NIDEK AFC-230; nonmydriatic fundus photograph
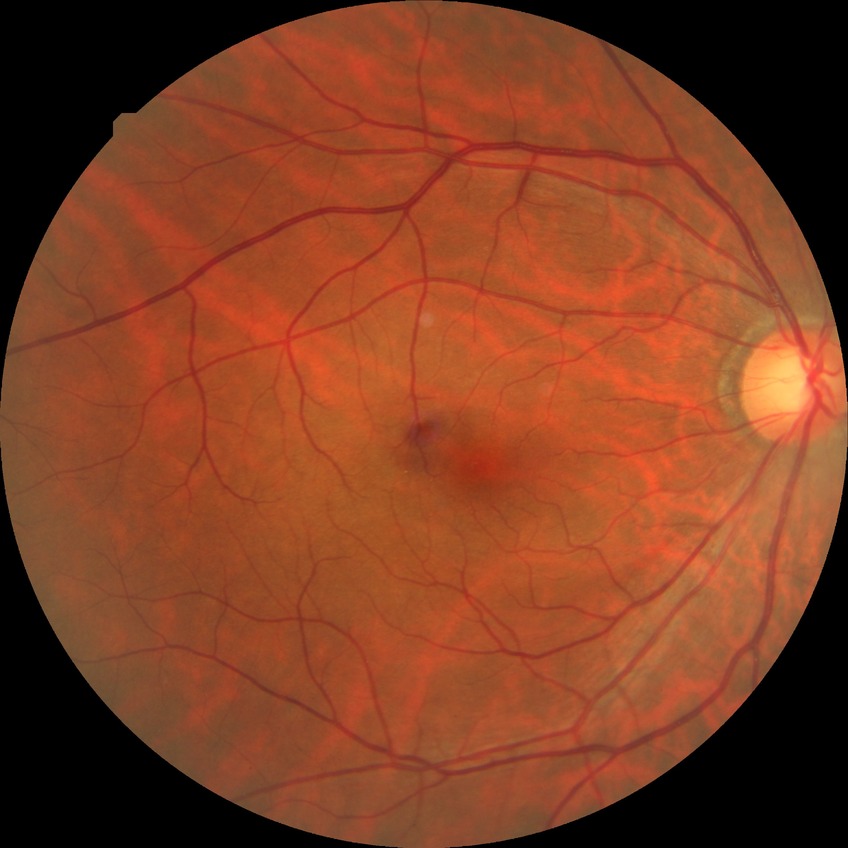
Diabetic retinopathy (DR) is SDR (simple diabetic retinopathy).